Infant wide-field fundus photograph — 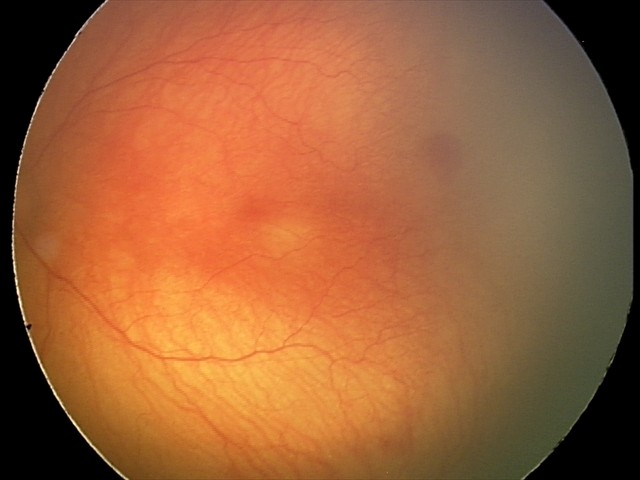 Impression: aggressive retinopathy of prematurity, plus form: present — abnormal dilation and tortuosity of the posterior pole retinal vessels.